640 by 480 pixels · Clarity RetCam 3, 130° FOV · wide-field contact fundus photograph of an infant:
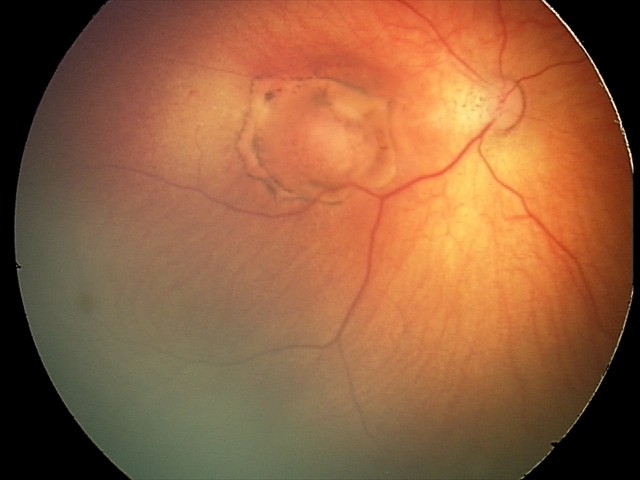
Screening series with toxoplasmosis chorioretinitis.